1932x1932
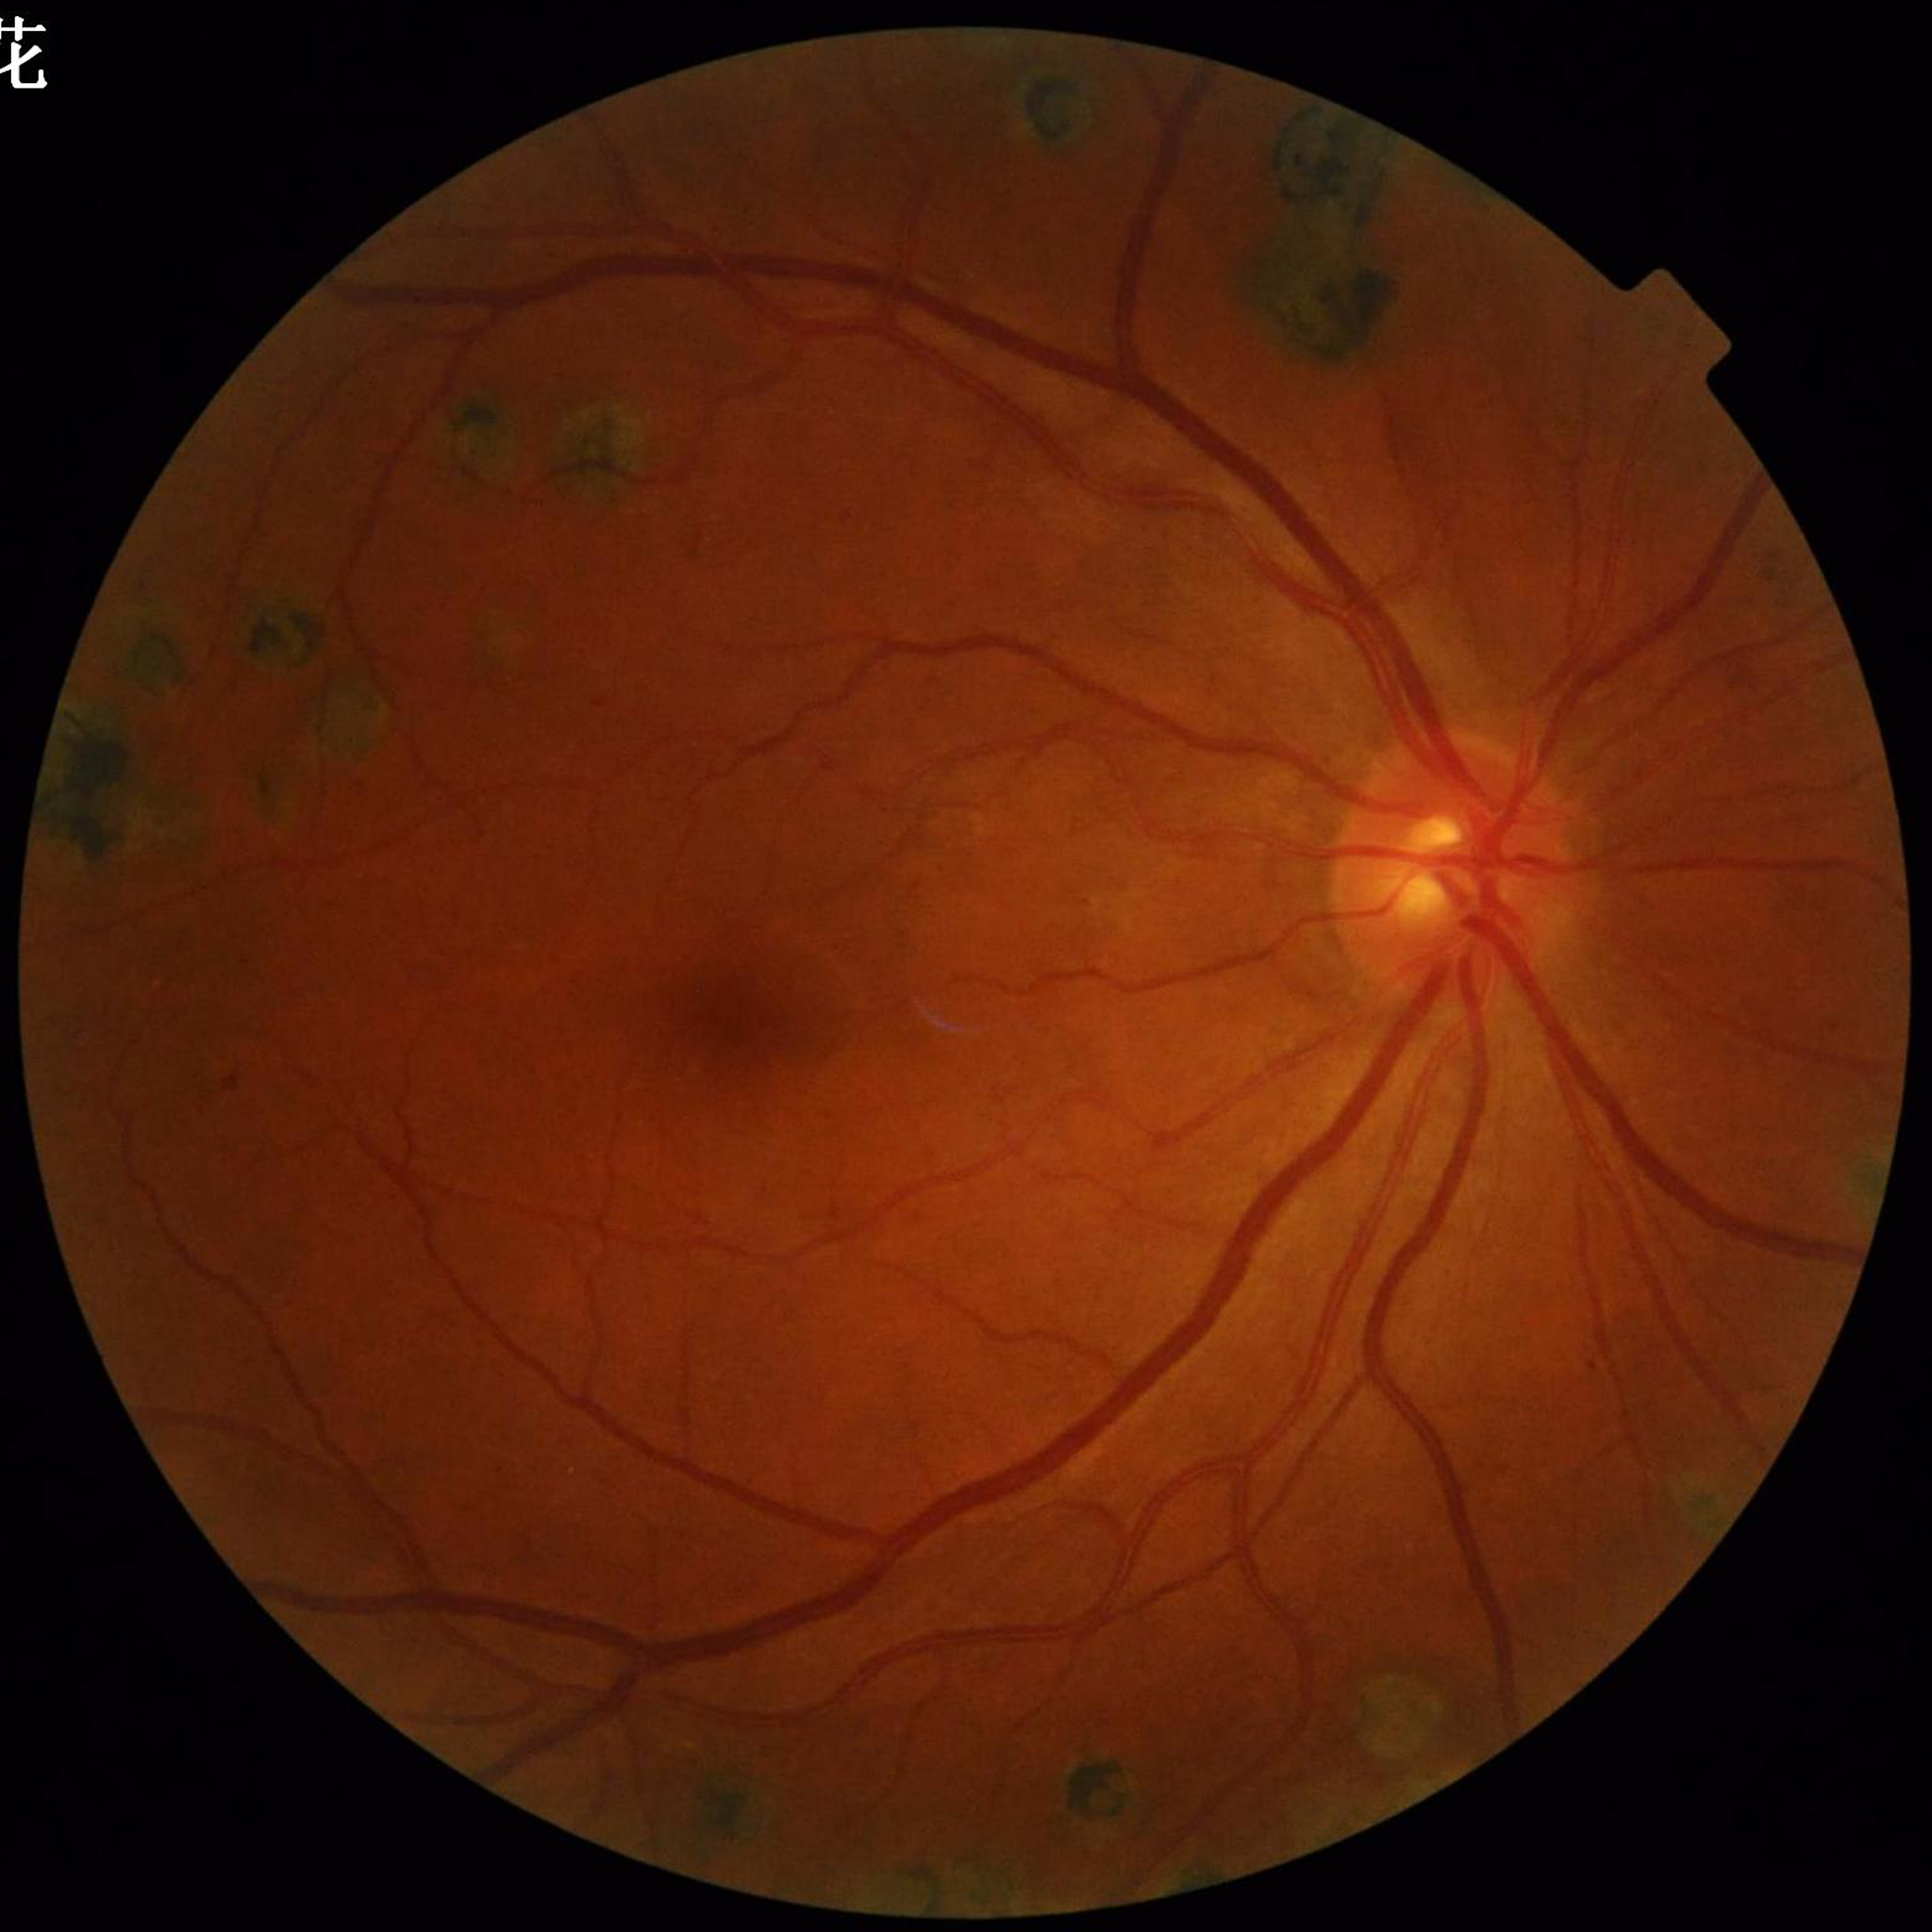 Color fundus photo. Patient diagnosed with diabetic retinopathy (DR).